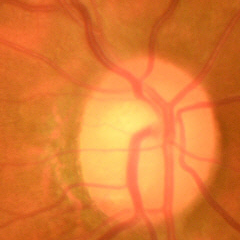 Glaucomatous optic neuropathy is present.
Early glaucoma.